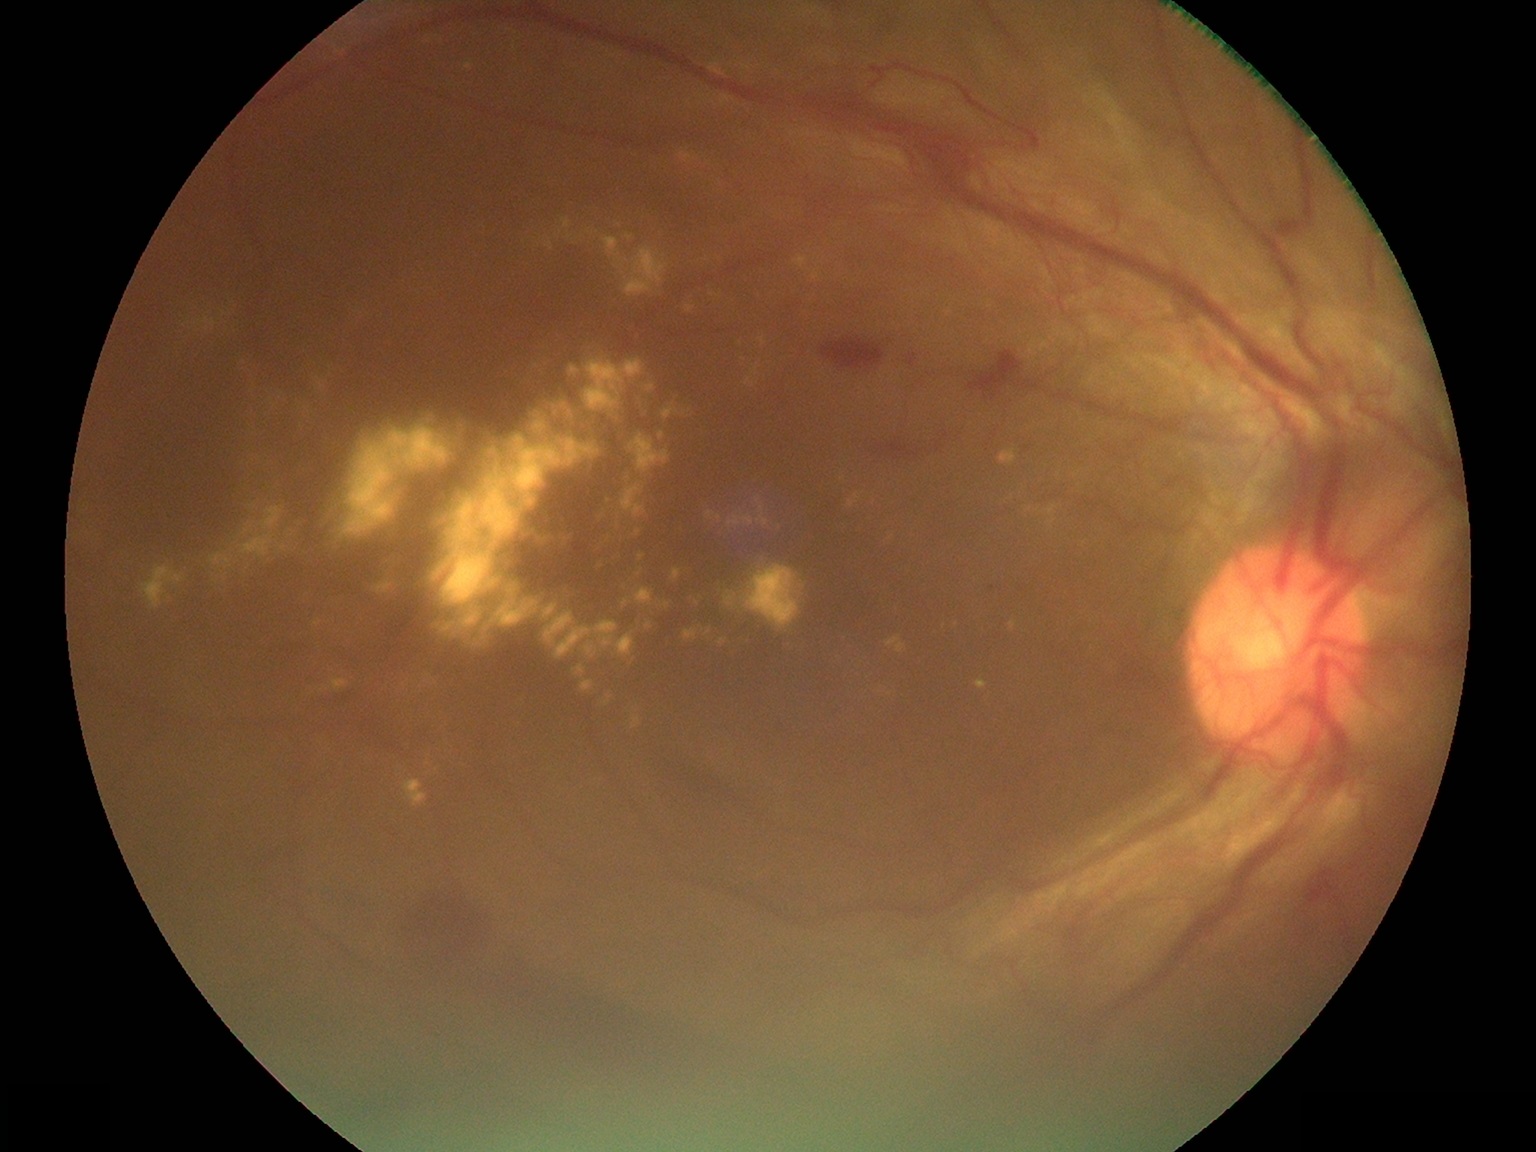

Diabetic retinopathy (DR): grade 4 — neovascularization and/or vitreous/pre-retinal hemorrhage. Hard exudates (EXs) are present, including at x1=551, y1=401, x2=573, y2=420 | x1=647, y1=384, x2=655, y2=392 | x1=313, y1=377, x2=328, y2=392 | x1=277, y1=544, x2=288, y2=552 | x1=684, y1=302, x2=696, y2=314 | x1=629, y1=715, x2=642, y2=729 | x1=394, y1=489, x2=403, y2=502 | x1=339, y1=418, x2=459, y2=541 | x1=629, y1=434, x2=670, y2=476 | x1=555, y1=227, x2=563, y2=240 | x1=728, y1=515, x2=754, y2=527 | x1=646, y1=622, x2=654, y2=629. EXs (small, approximate centers) near [282,395] | [709,632] | [484,639] | [213,575] | [609,501] | [301,426].